50° FOV, color fundus image
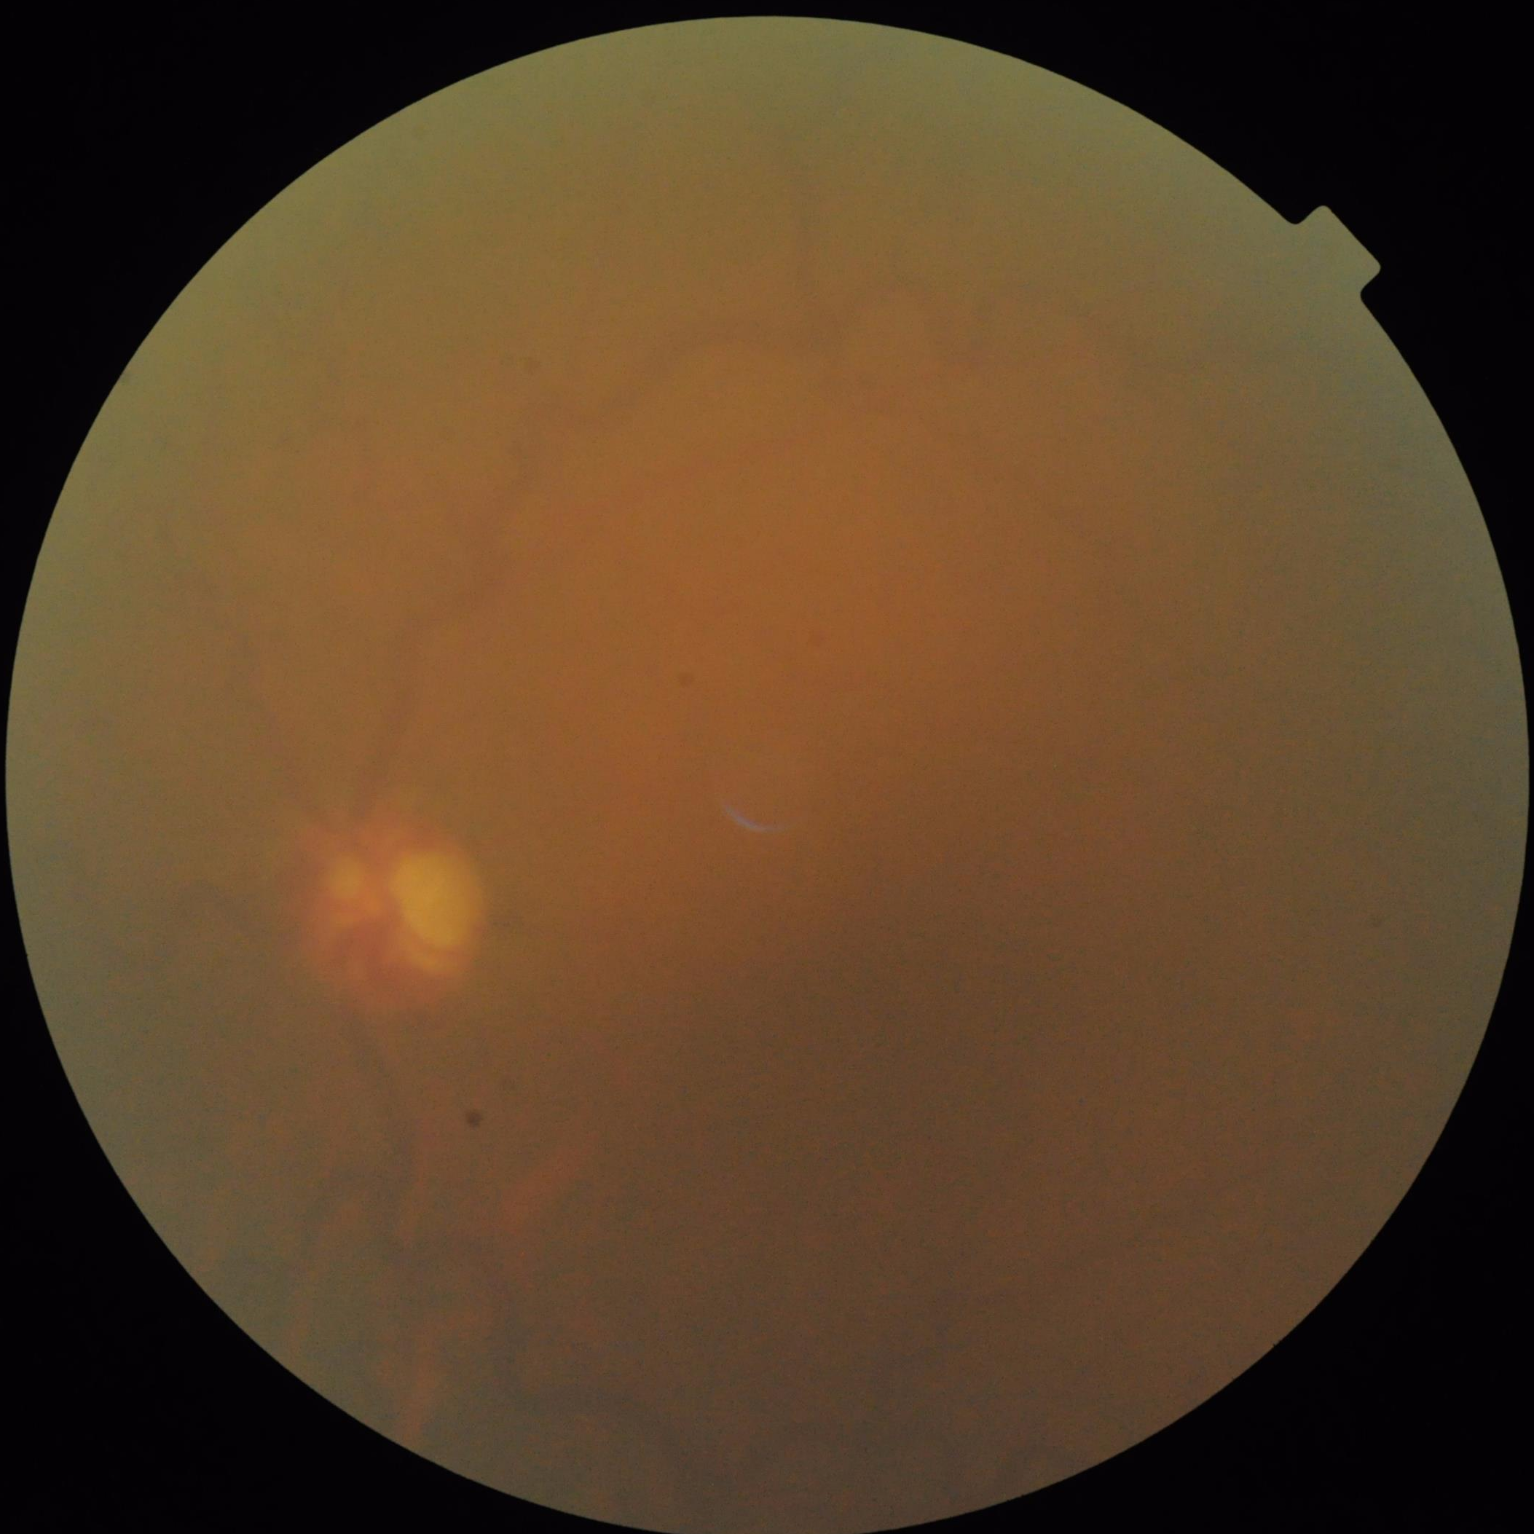

The image is blurry. Vessels and details are hard to distinguish. Image quality is inadequate for diagnostic use. There is over- or under-exposure or a color cast.